1659x2212px; fundus photo; camera: Remidio smartphone fundus camera.
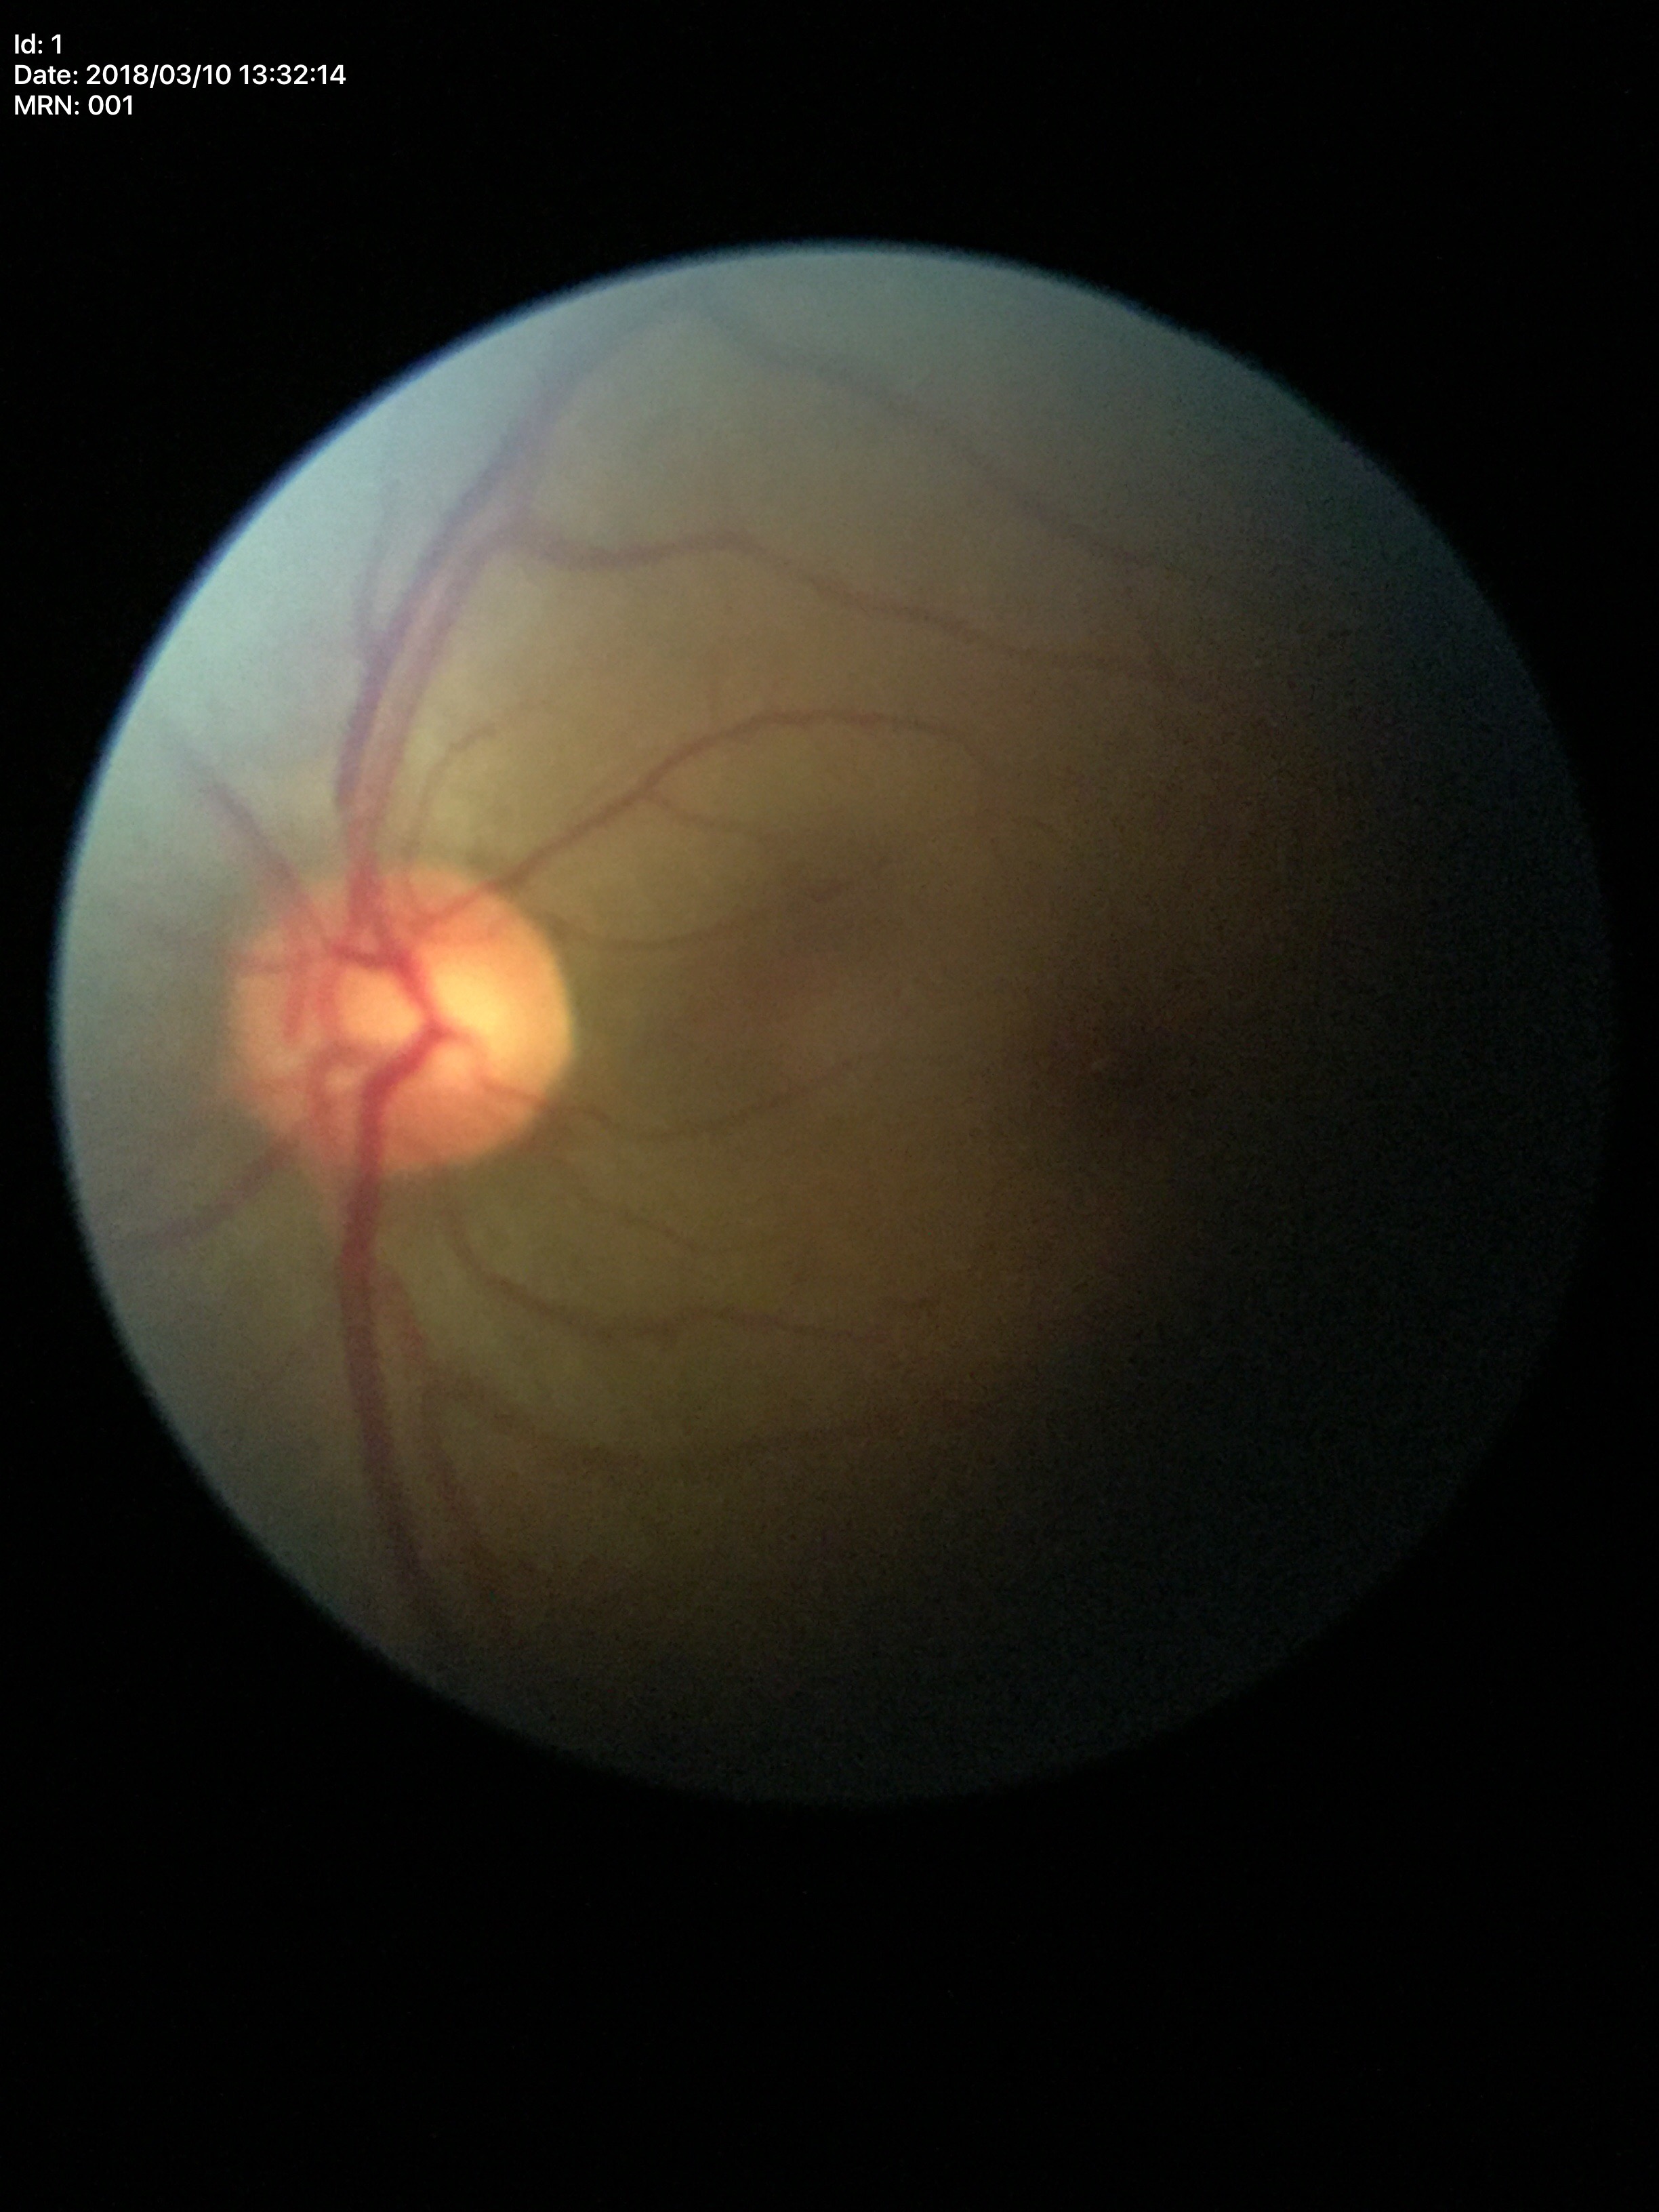

No signs of glaucoma. Vertical cup-disc ratio is 0.54.